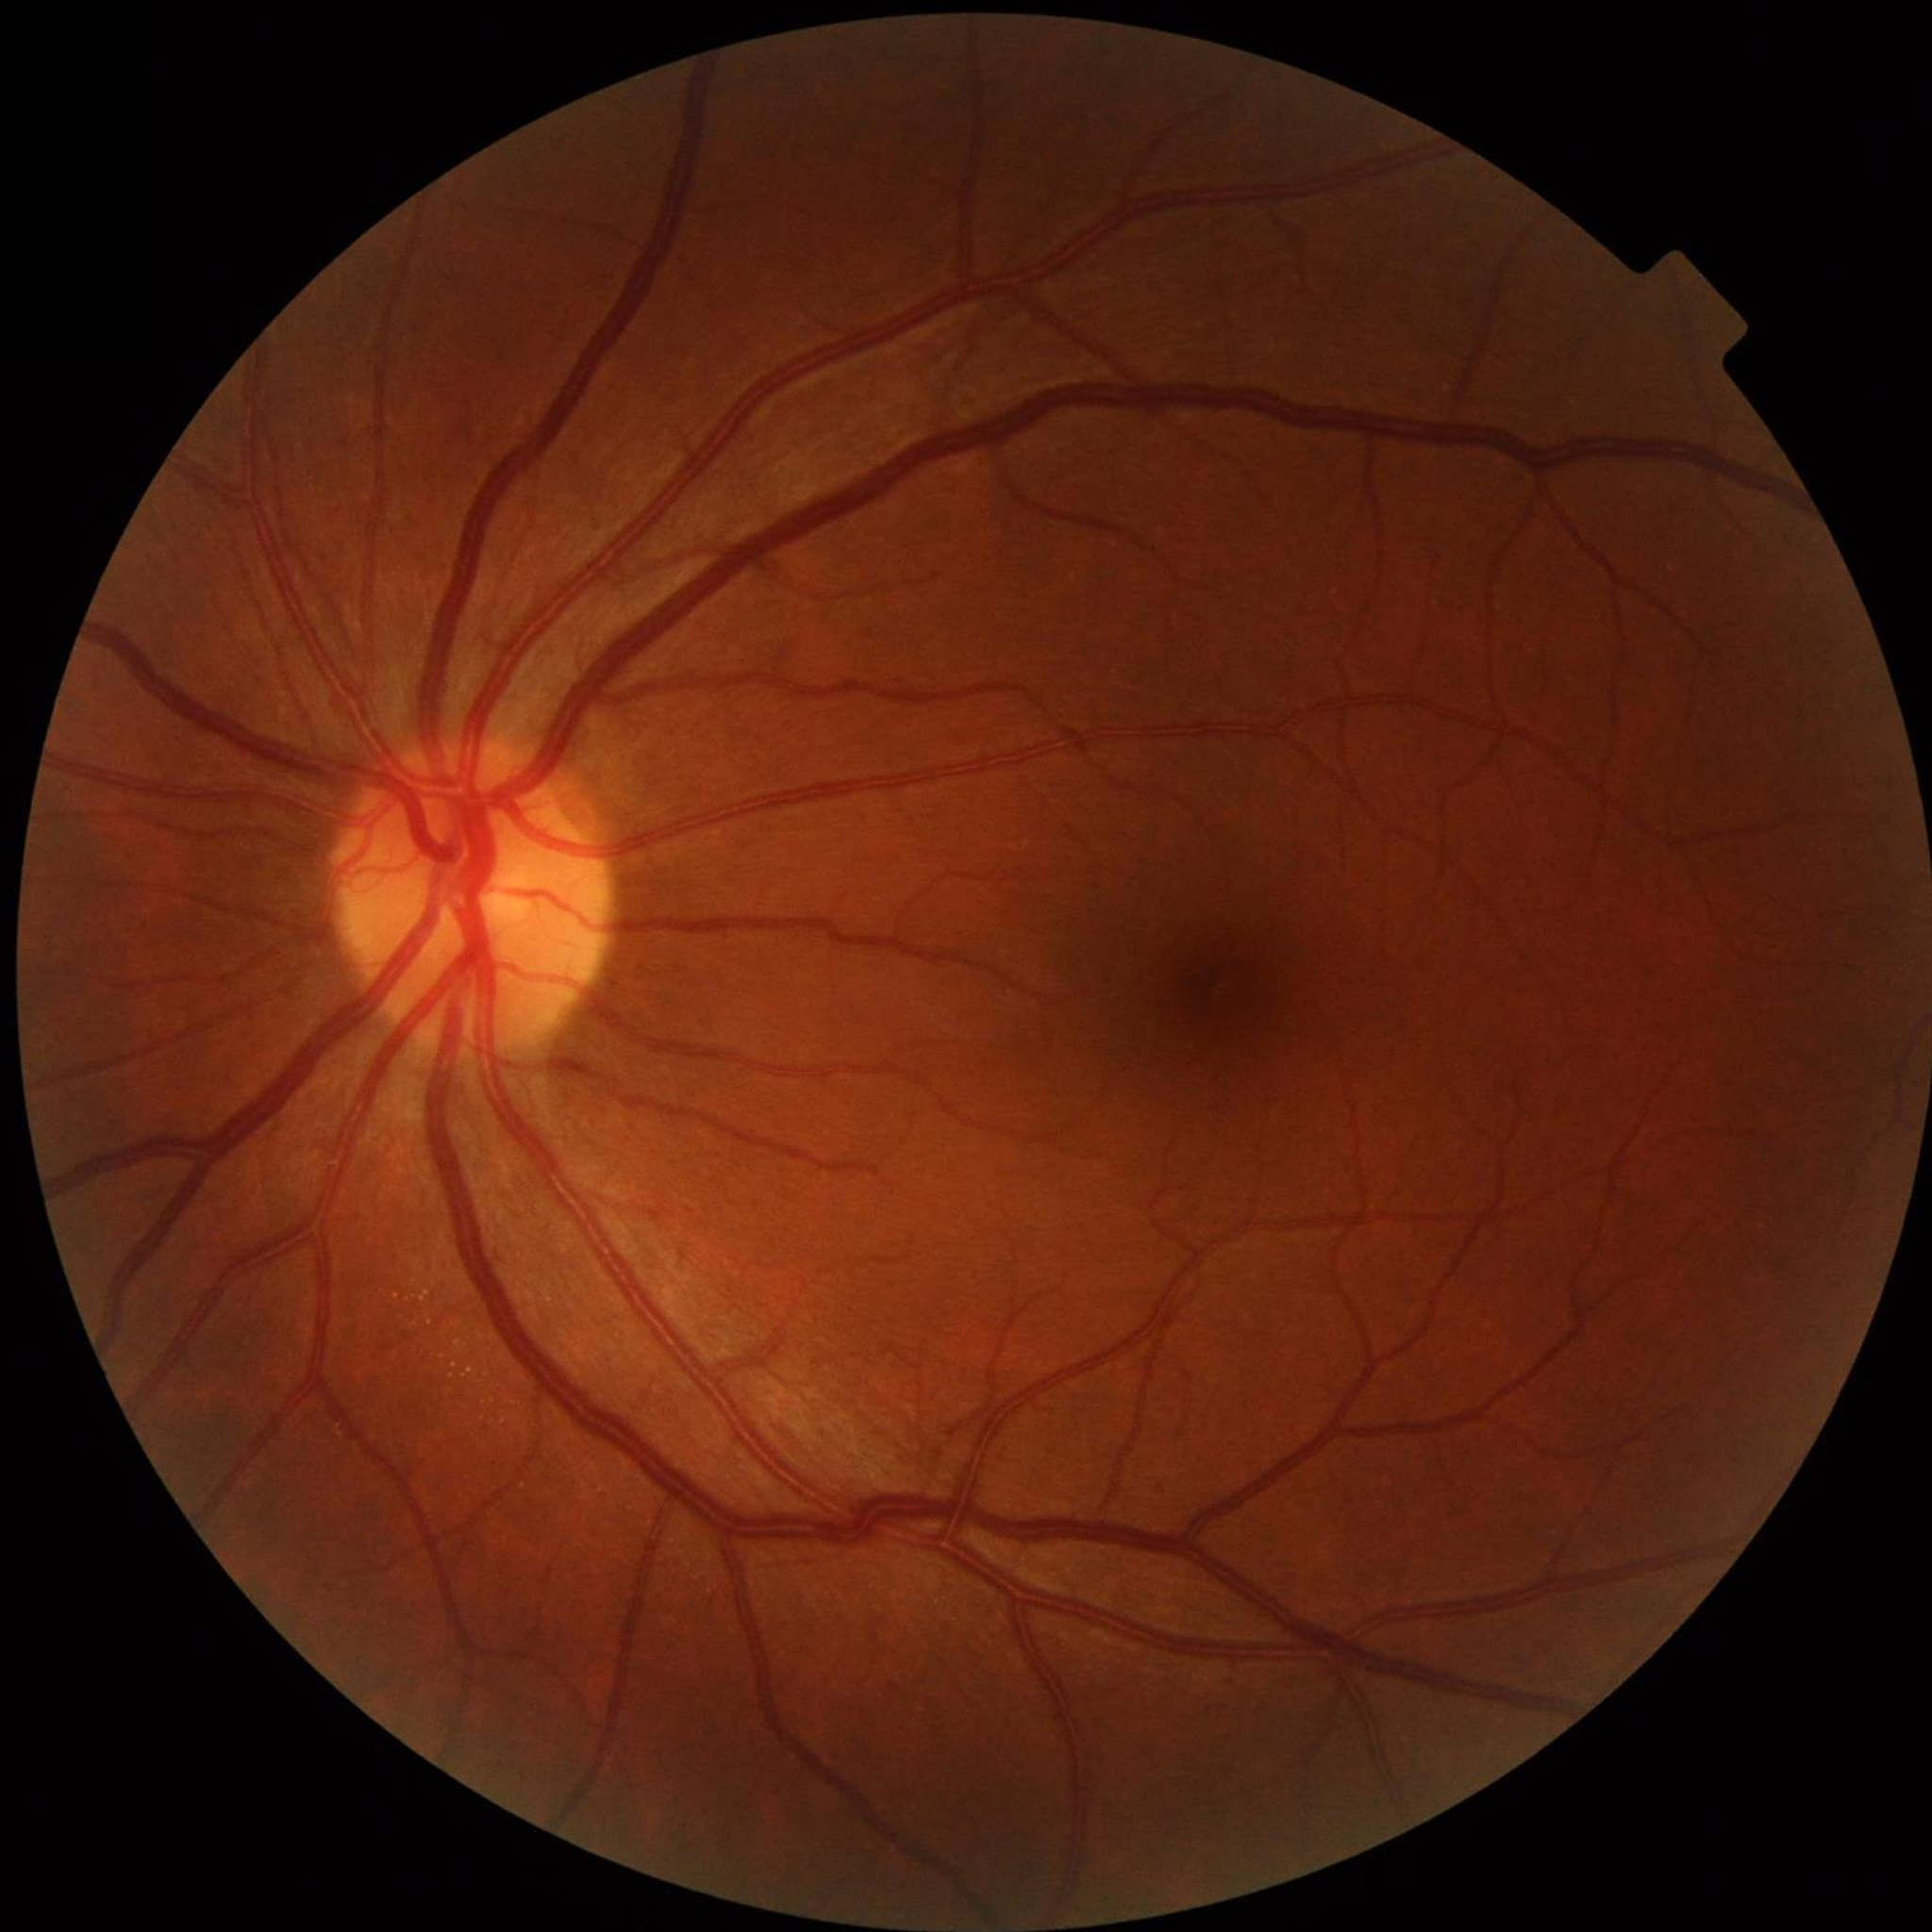 Quality assessment: adequate.
Control patient without diagnosed AMD, DR, or glaucoma.